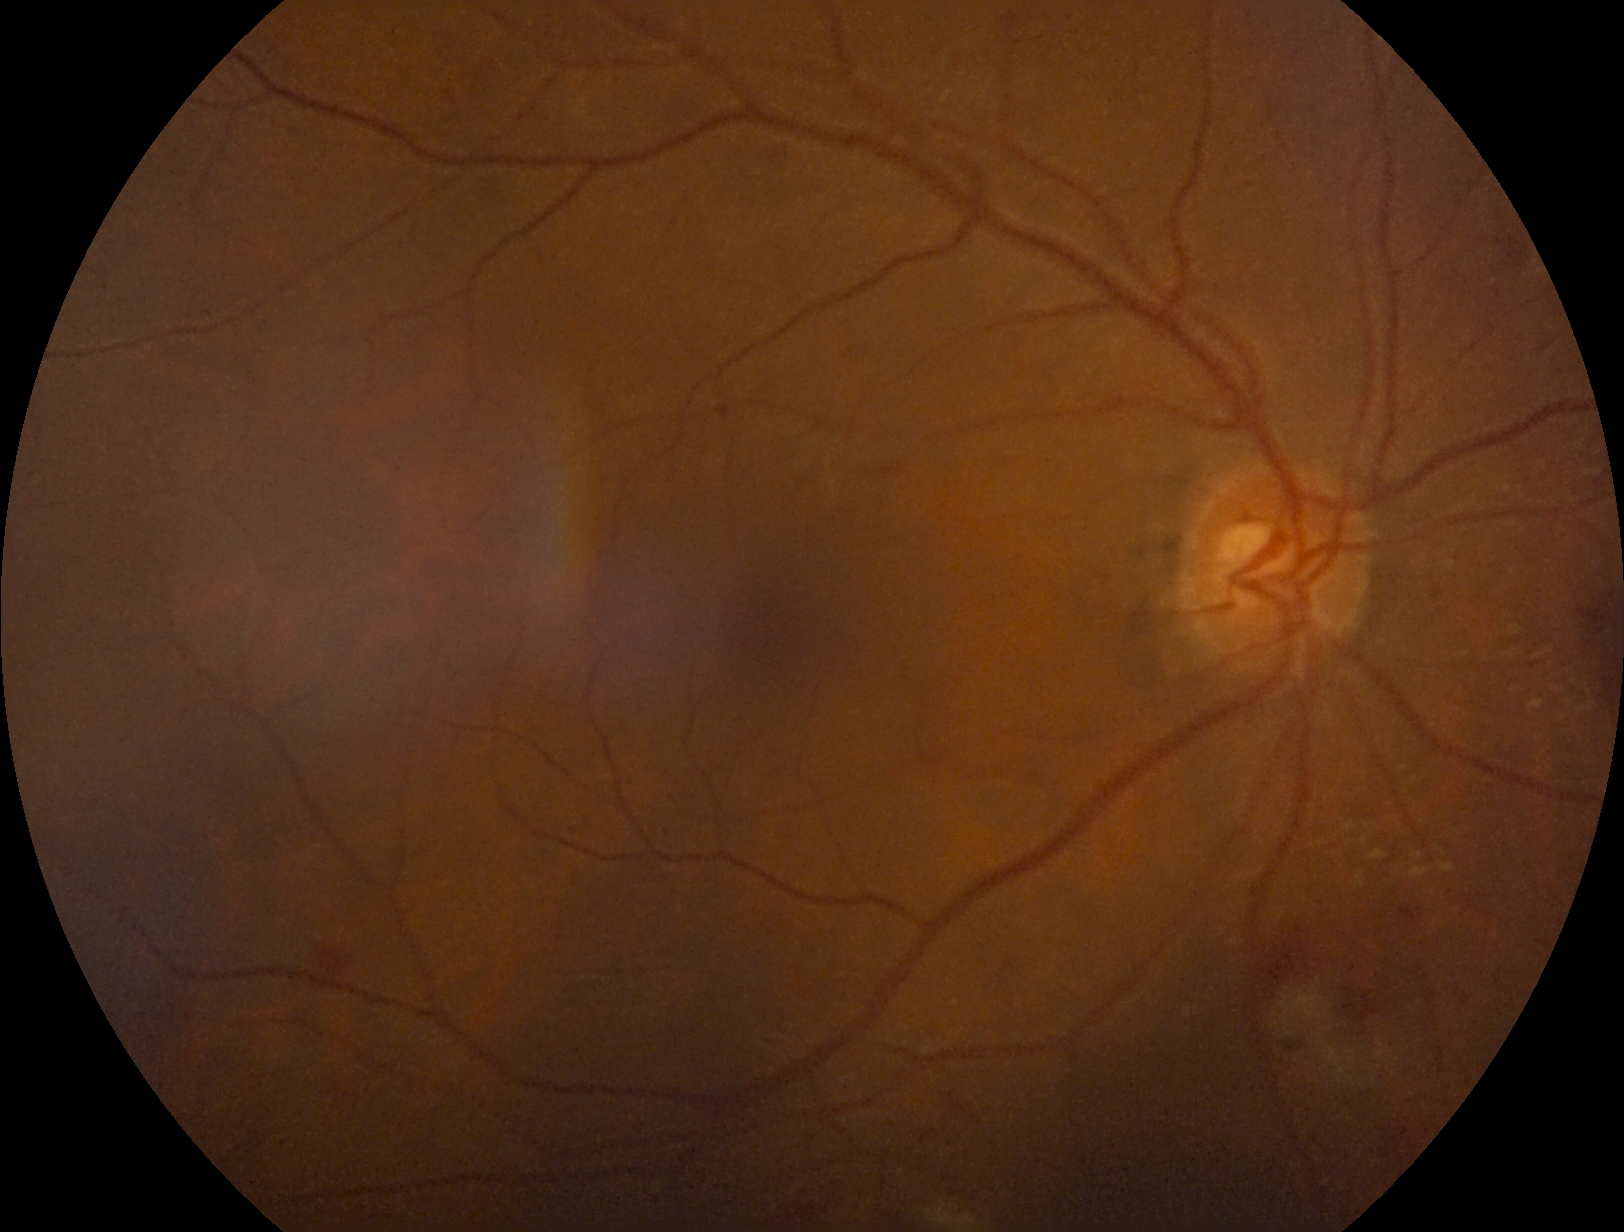
Diabetic retinopathy is moderate NPDR (grade 2).